Wide-field fundus image from infant ROP screening; captured with the Clarity RetCam 3 (130° field of view): 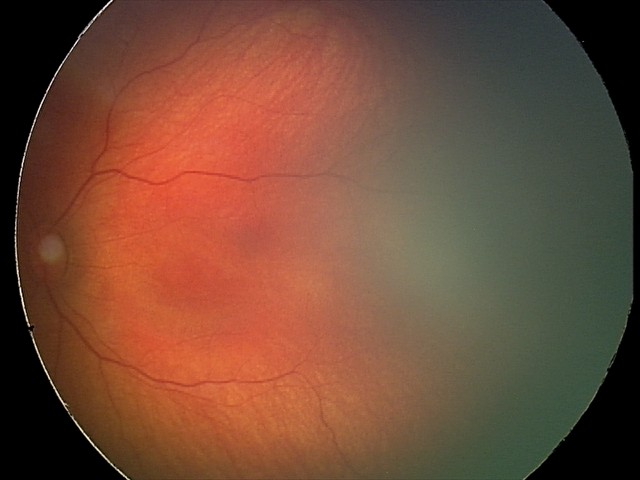
Physiological retinal appearance for postconceptual age.